CFP · 2089x1764px
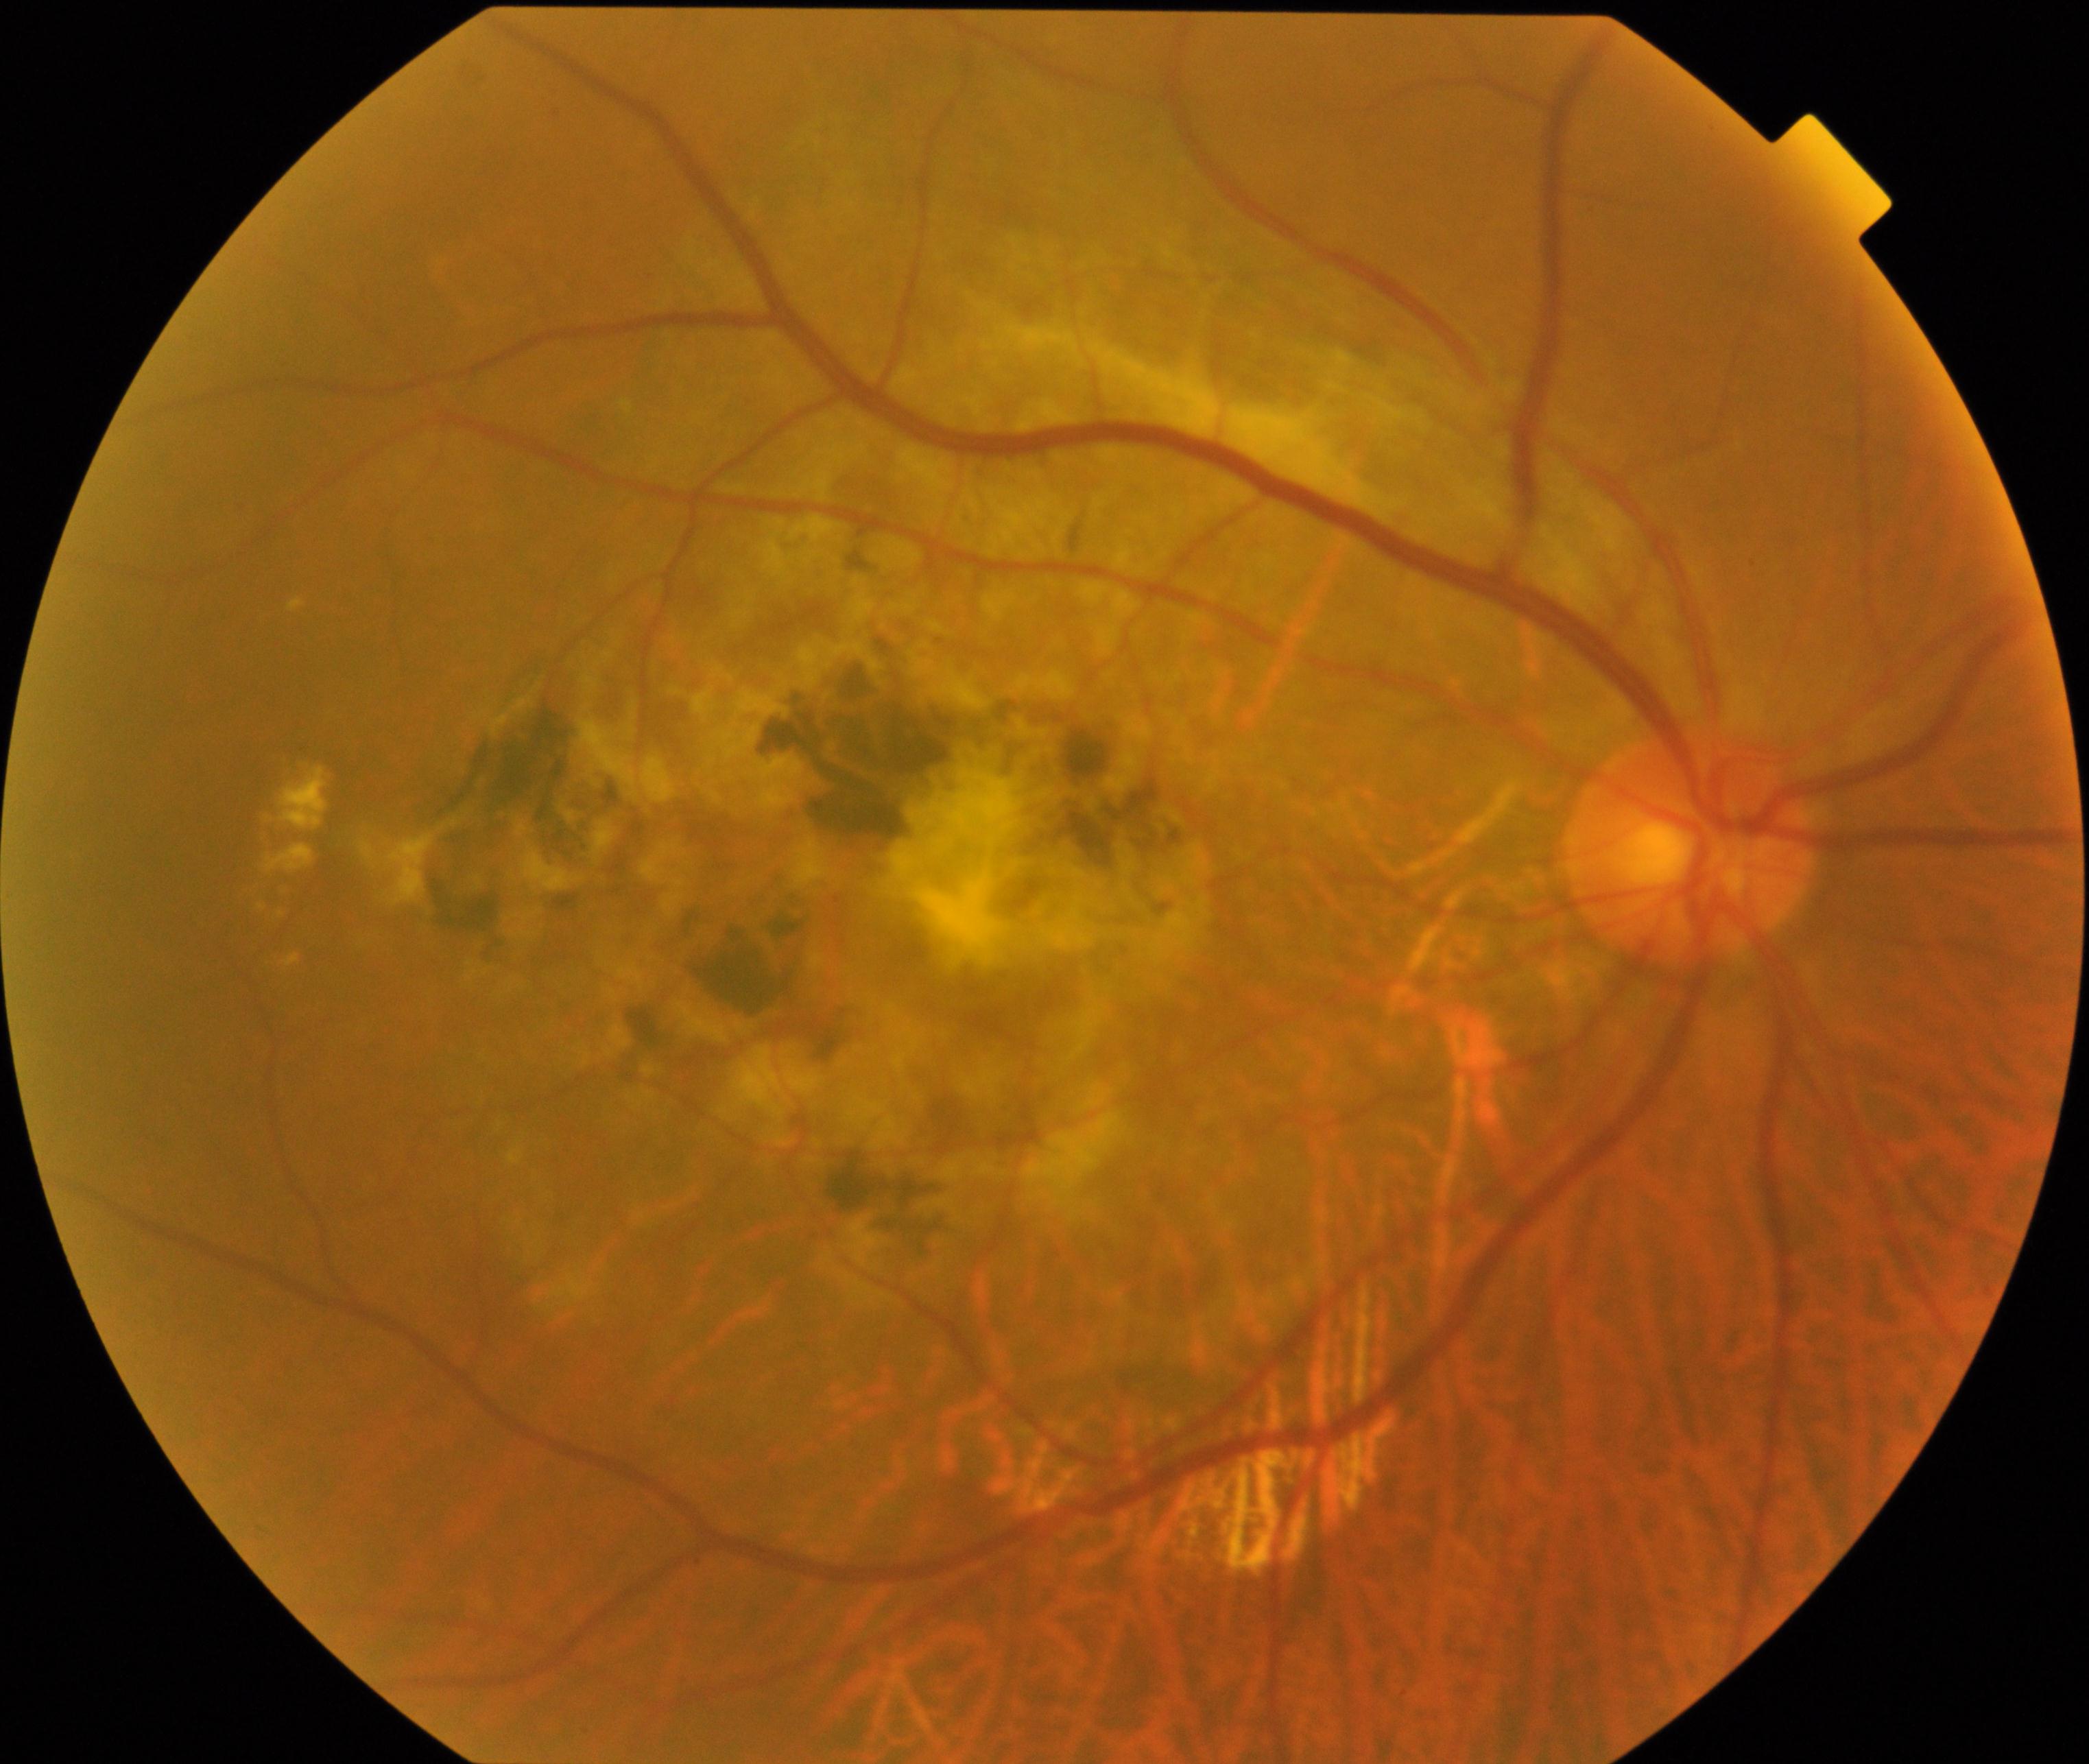

Consistent with maculopathy. Features include lesions within the macular area, such as intermediate or neovascular age-related macular degeneration, retinal angiomatous proliferation, polypoidal choroidal vasculopathy, choroidal neovascularization, idiopathic macular telangiectasia, and macular atrophy, not caused by other listed disease categories.